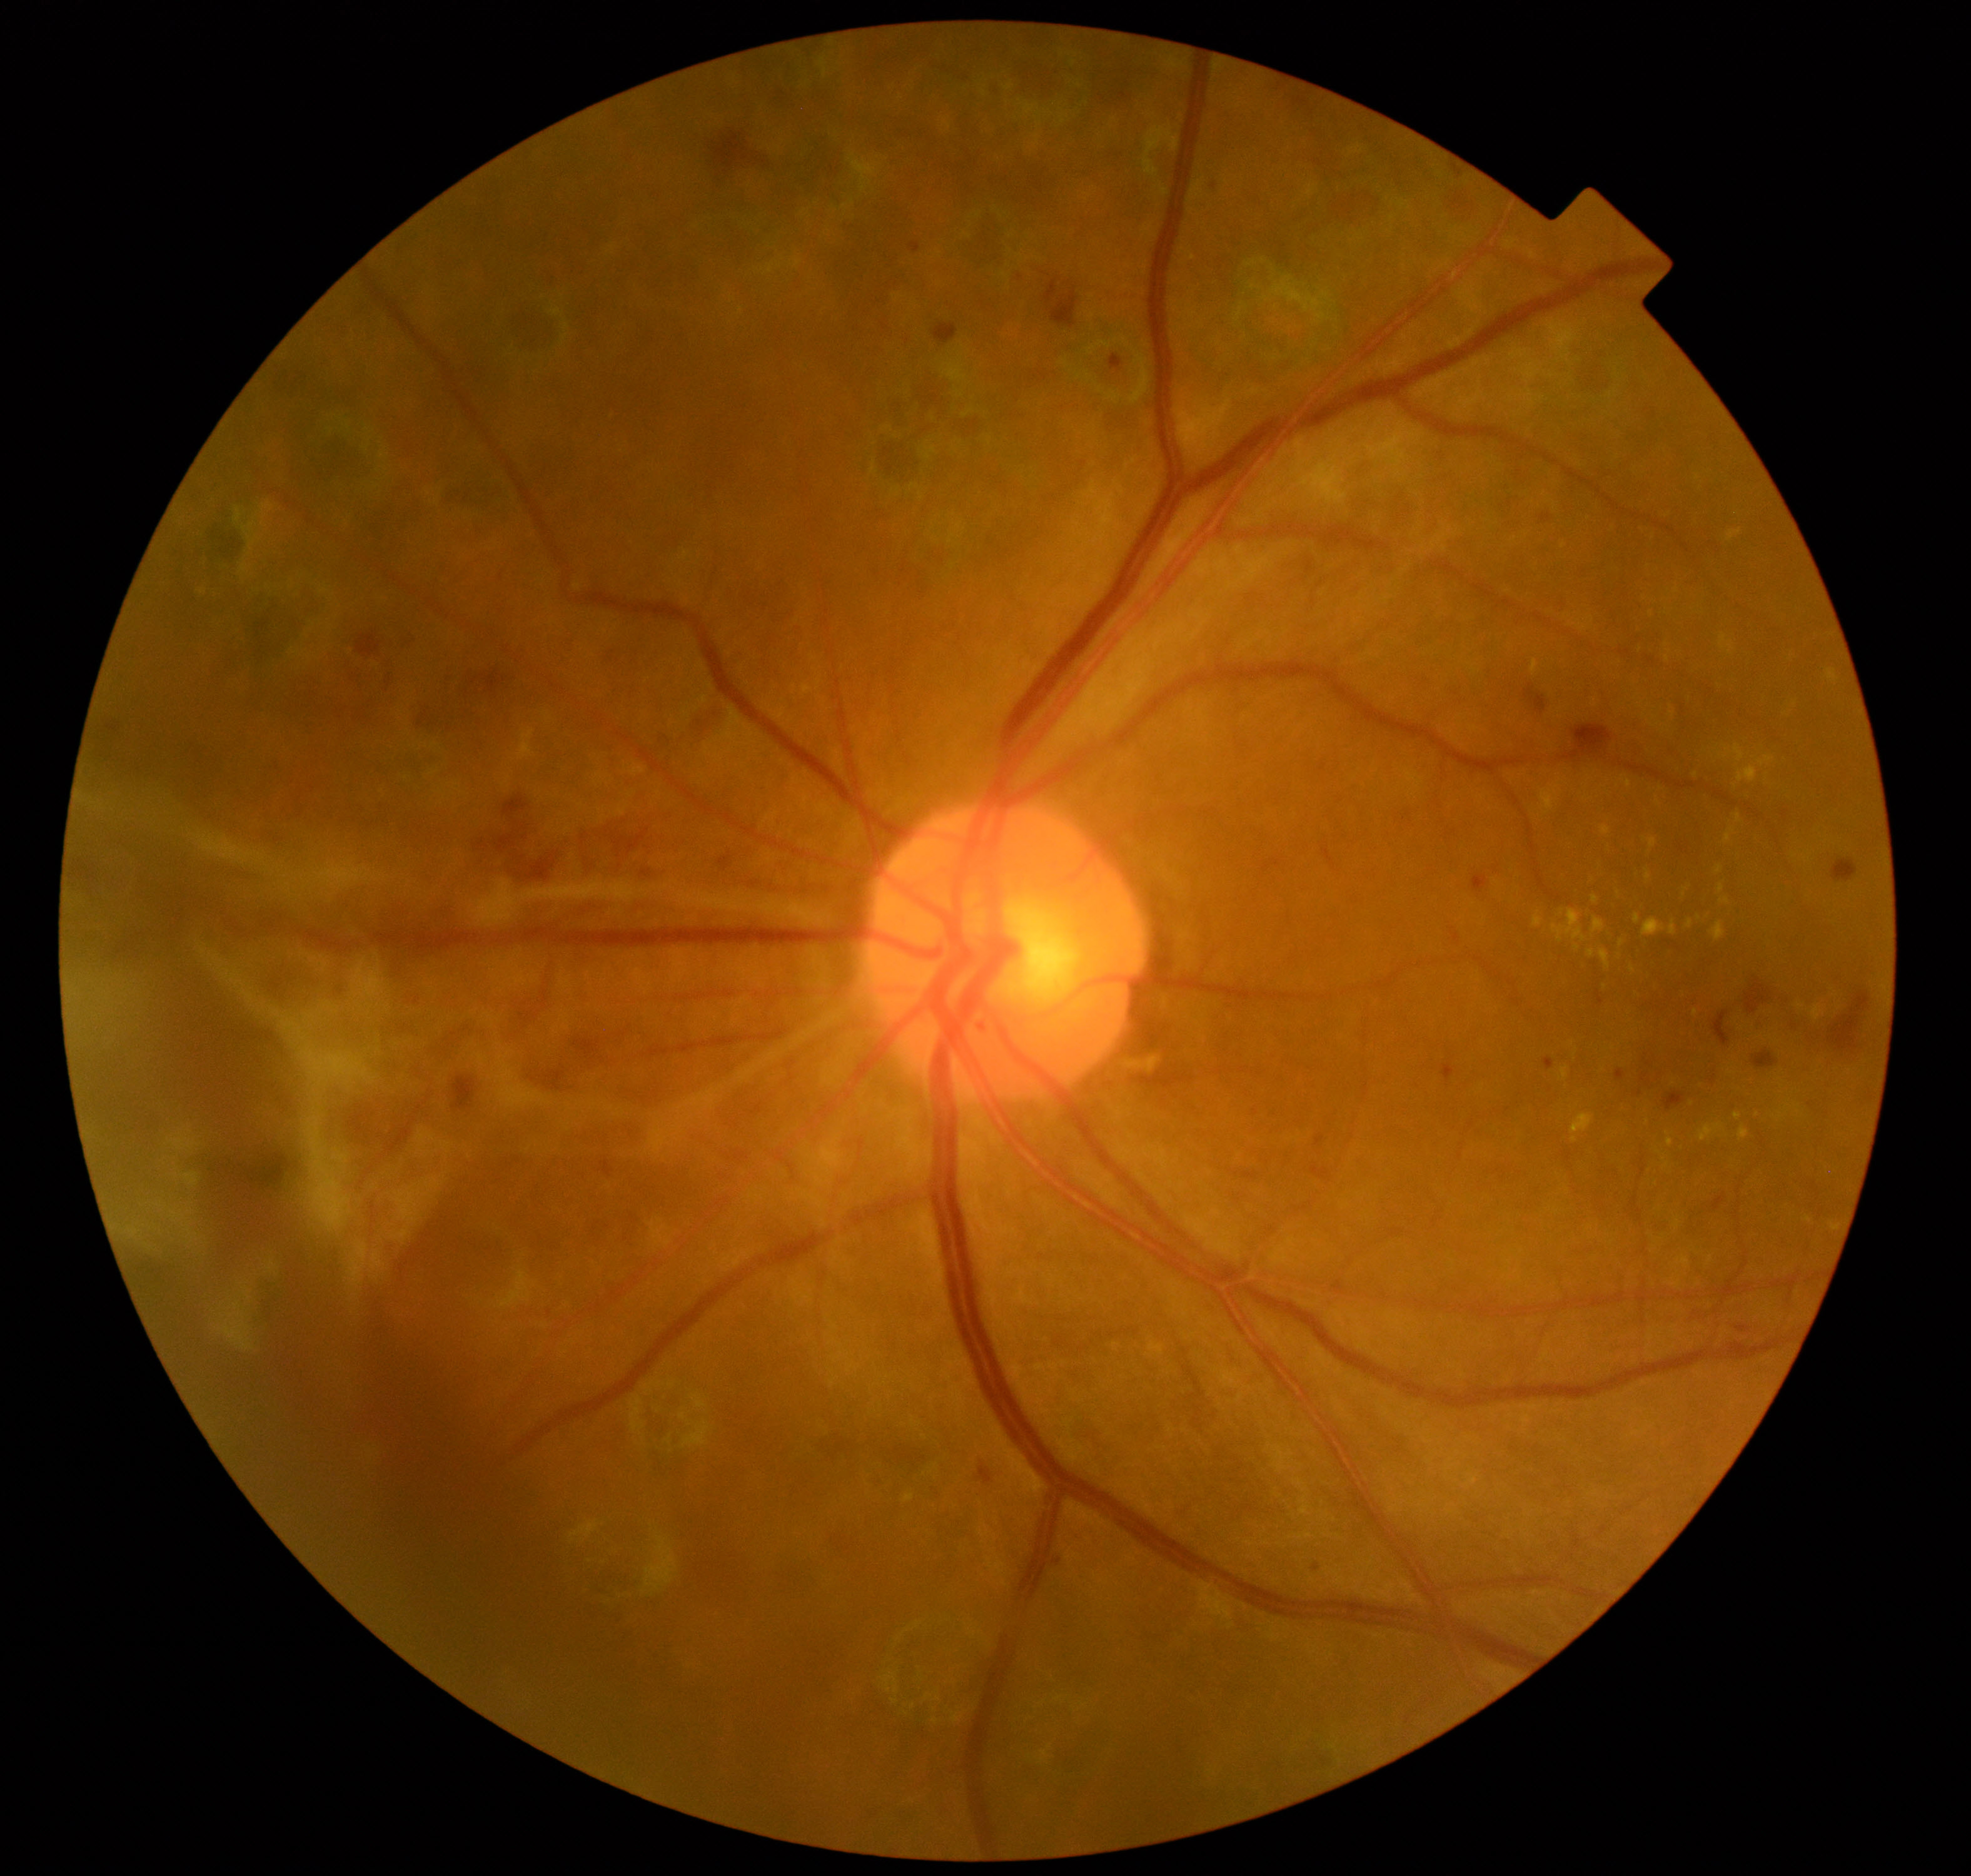
Impression: severe non-proliferative or proliferative diabetic retinopathy.